Wide-field fundus photograph from neonatal ROP screening.
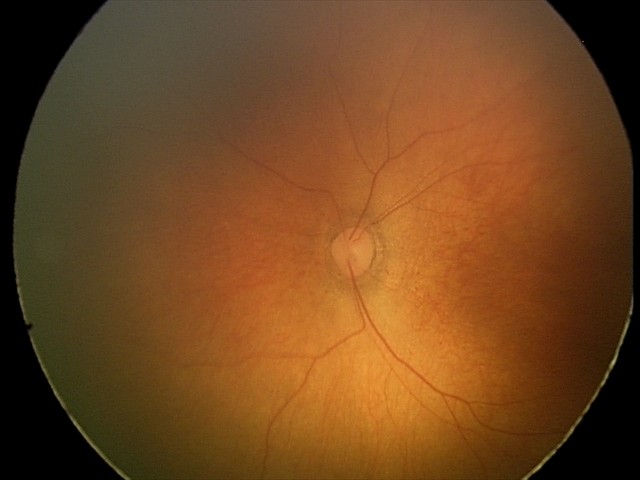
No retinal pathology identified on screening.